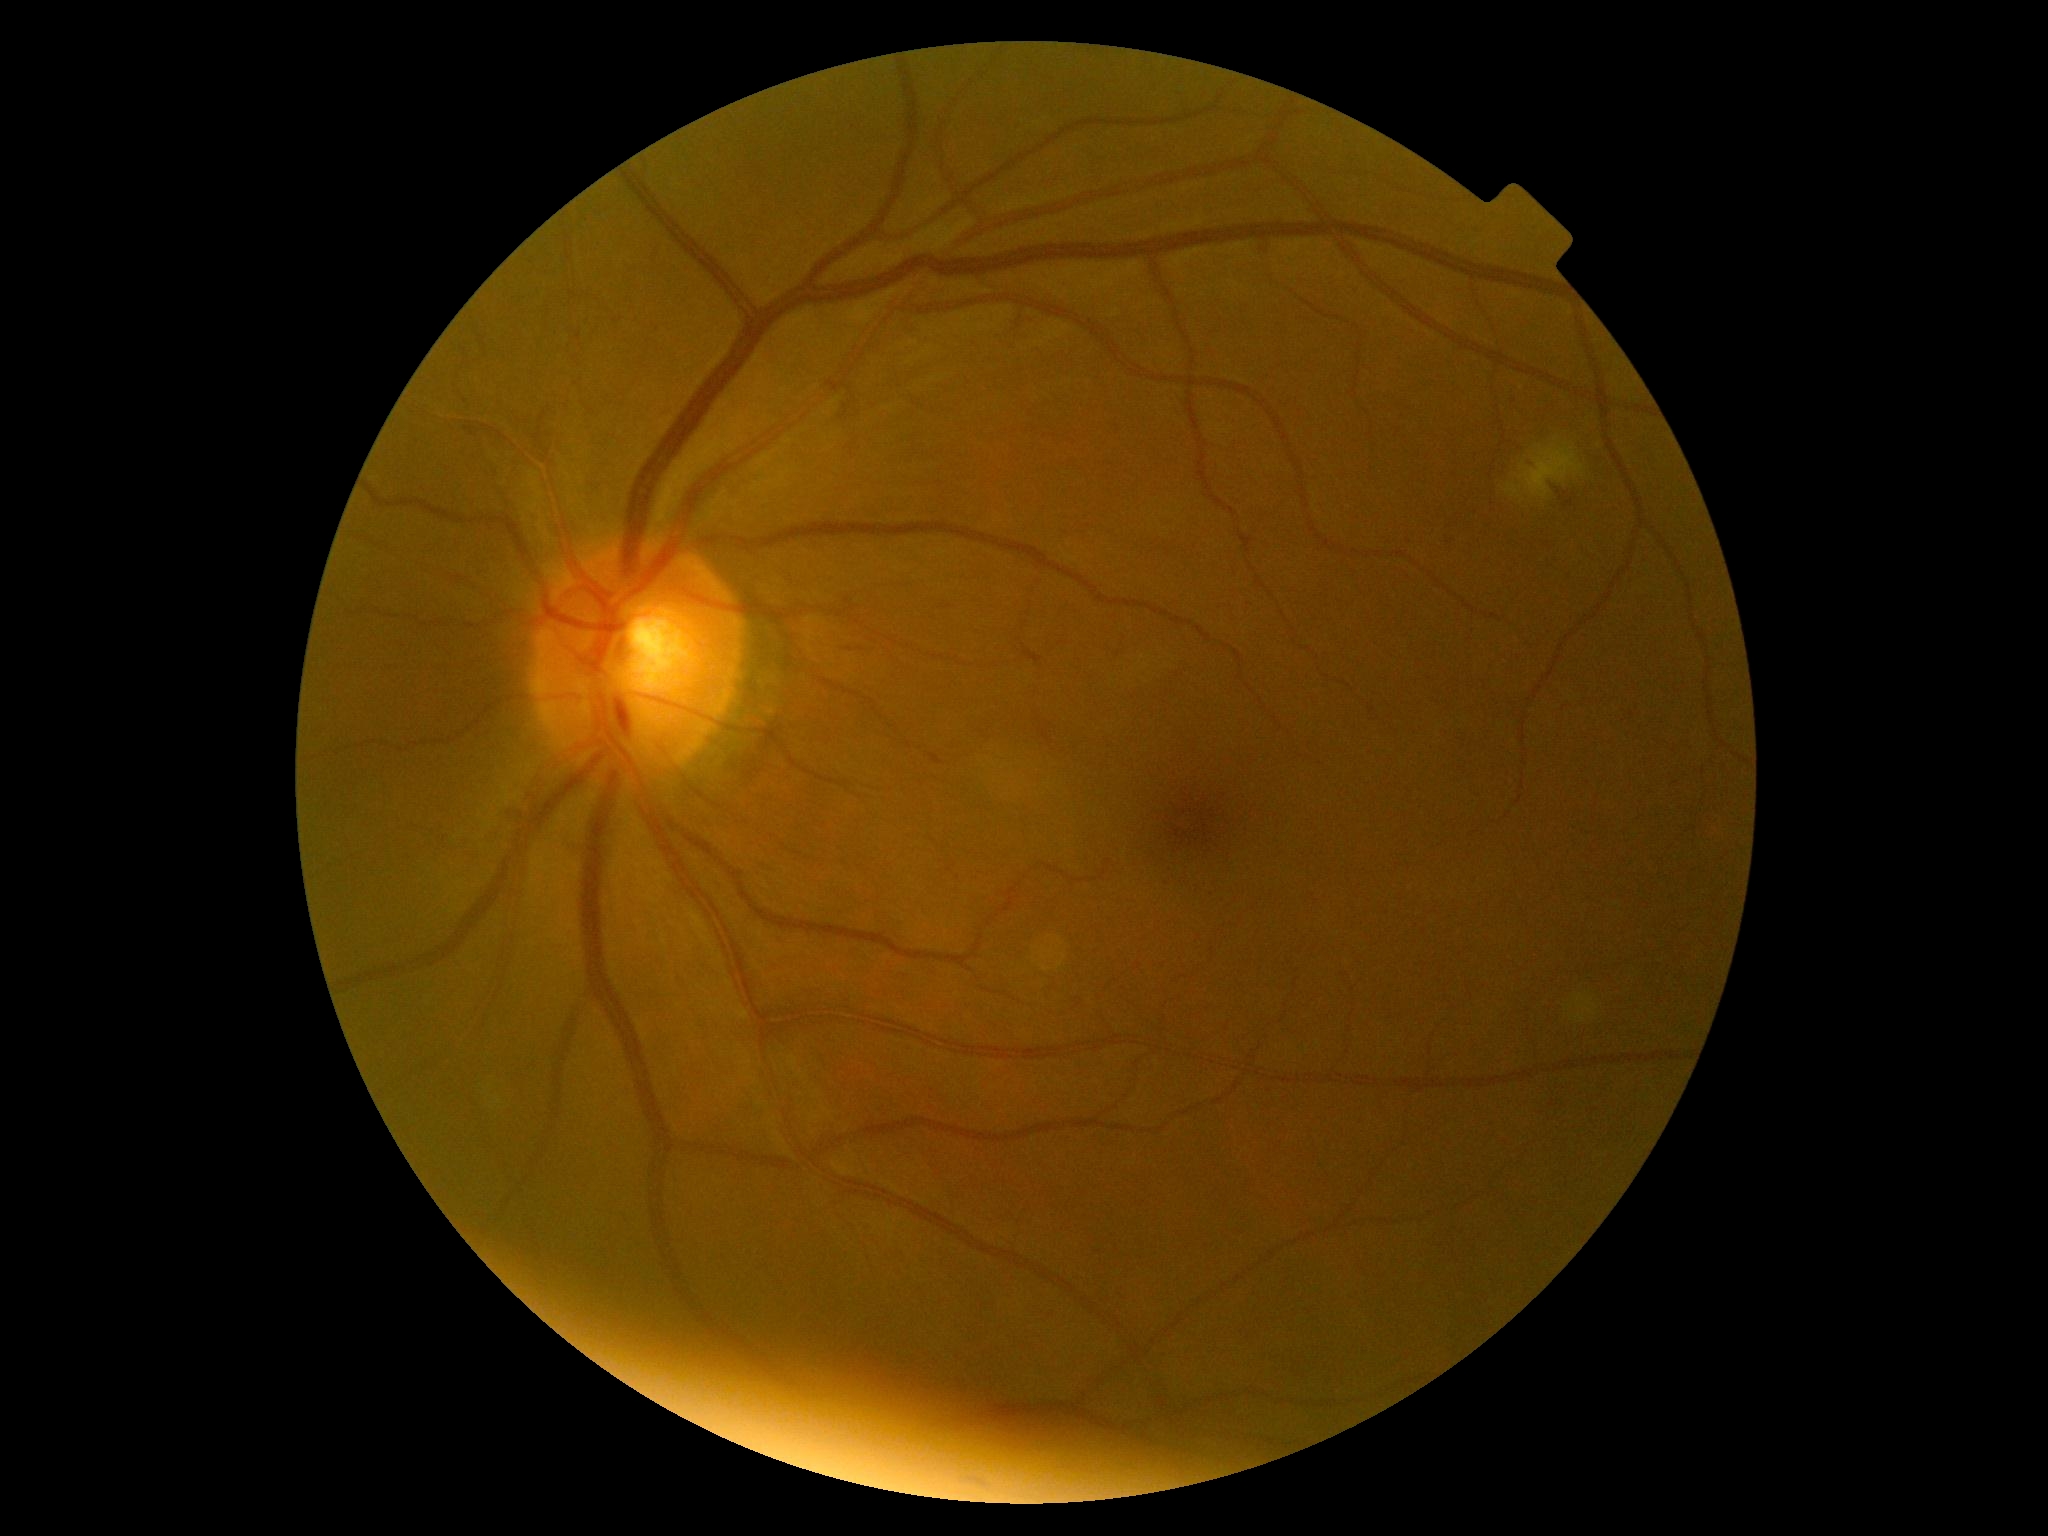 DR class: non-proliferative diabetic retinopathy, retinopathy: moderate non-proliferative diabetic retinopathy (grade 2).